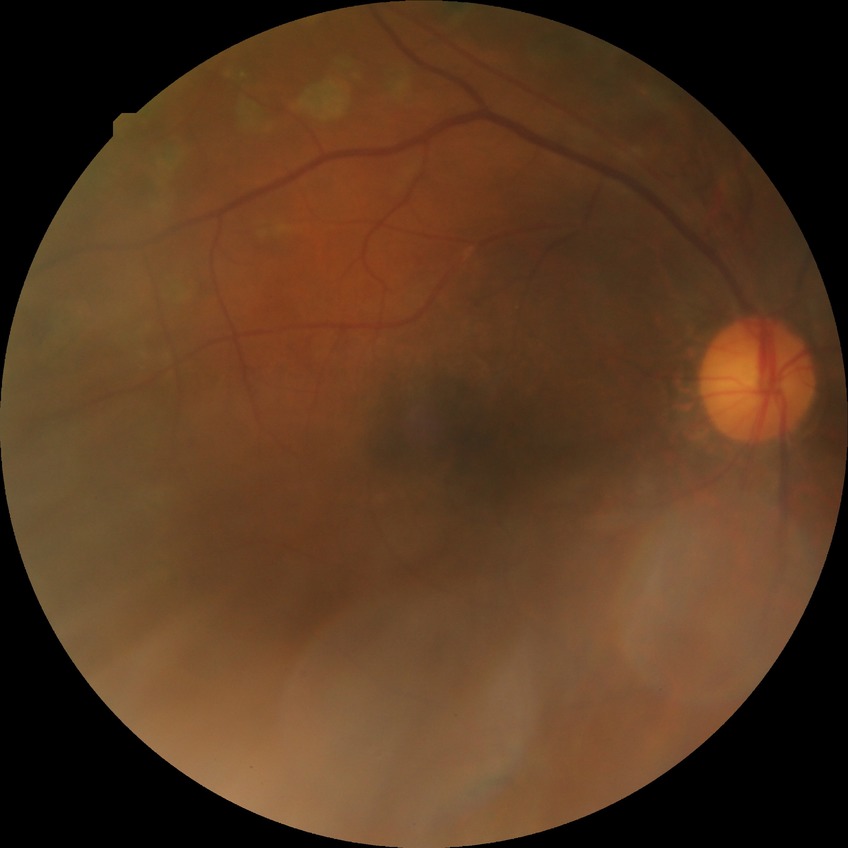

DR is PDR.